1240x1240px. Phoenix ICON wide-field infant fundus image. Camera: Phoenix ICON (100° FOV).
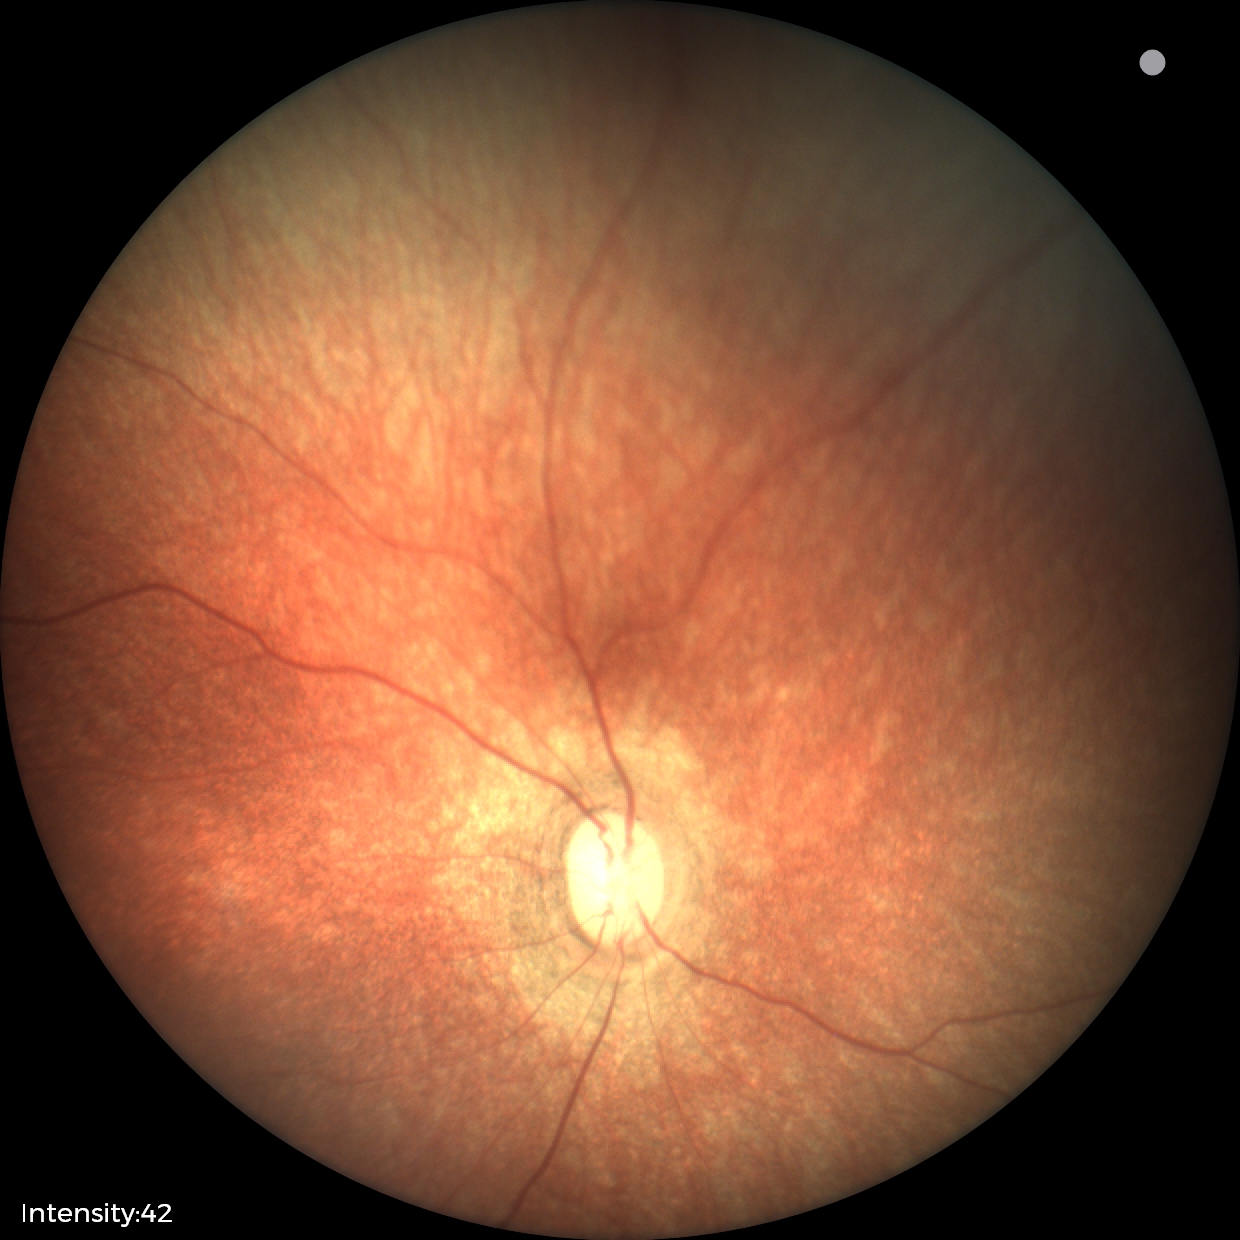 Screening diagnosis: physiological finding.